DR severity per modified Davis staging. 45° FOV: 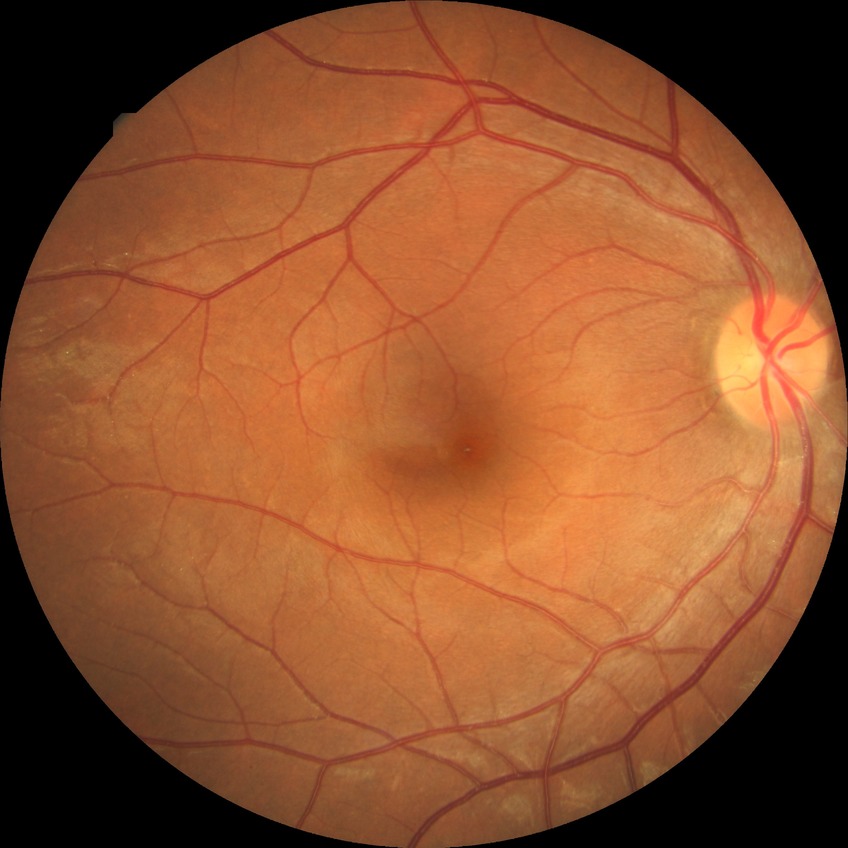

Retinopathy grade is no diabetic retinopathy.